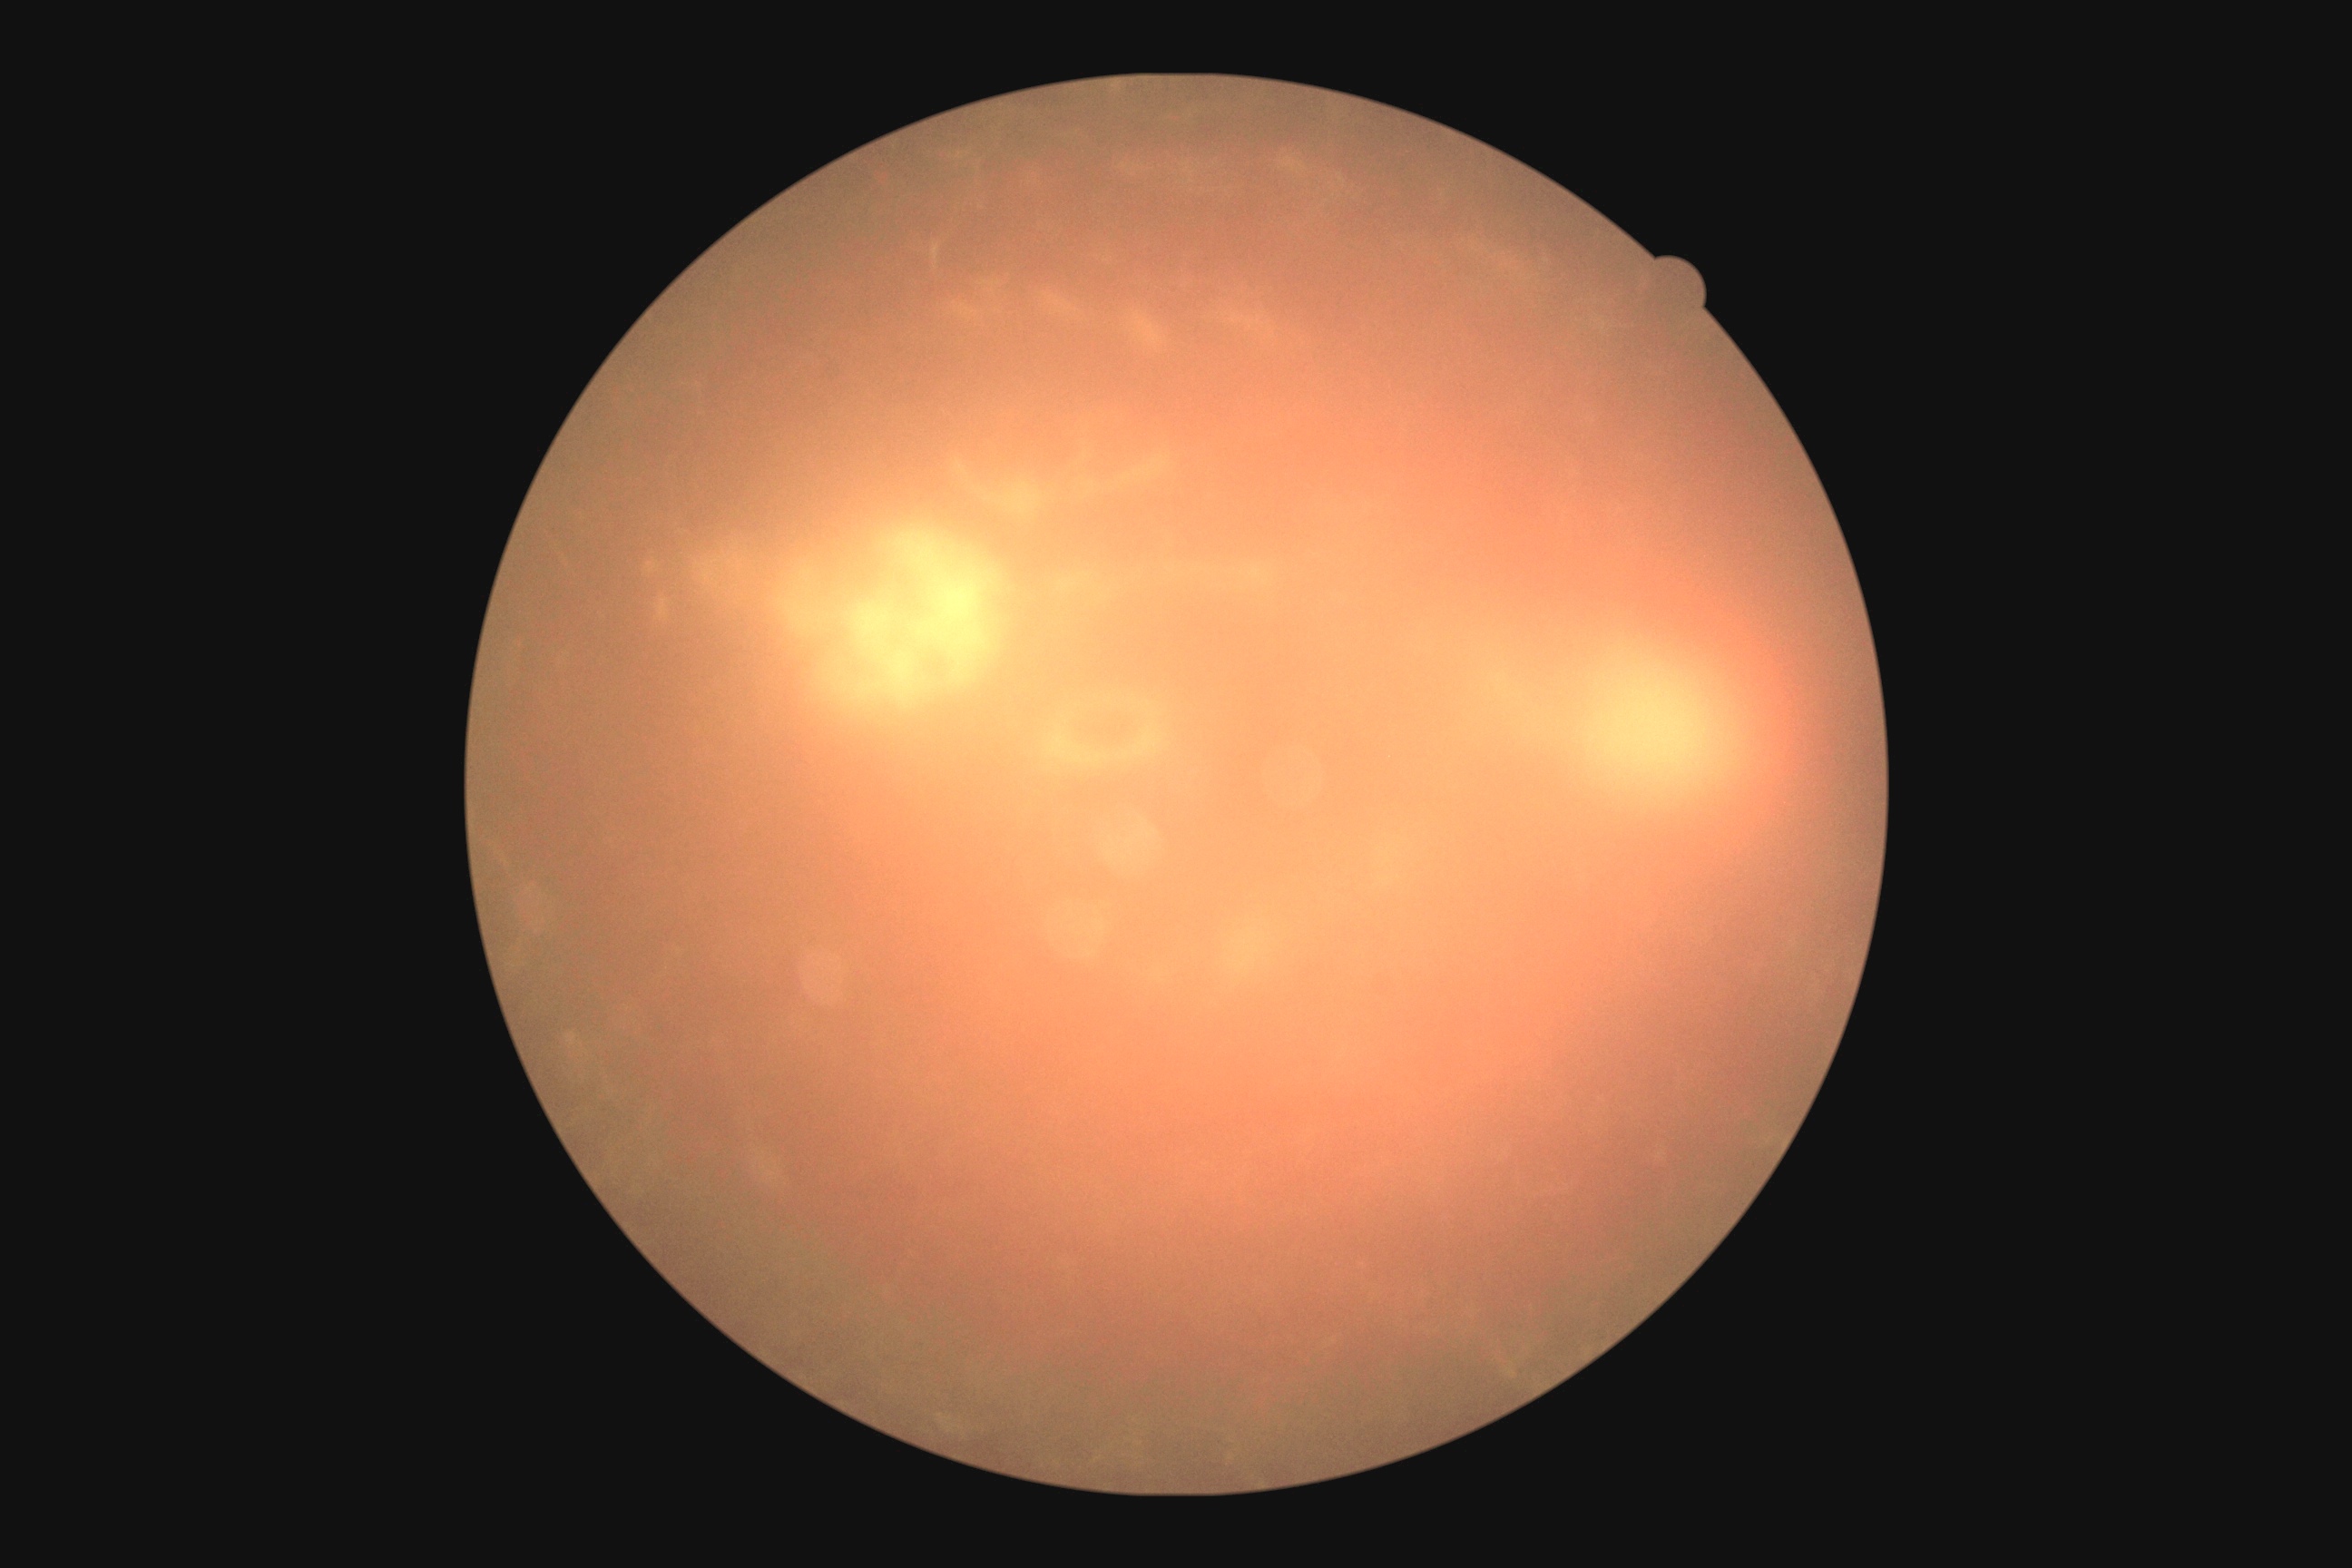
{"dr_grade": "ungradable due to poor image quality", "quality": "too poor for DR grading"}